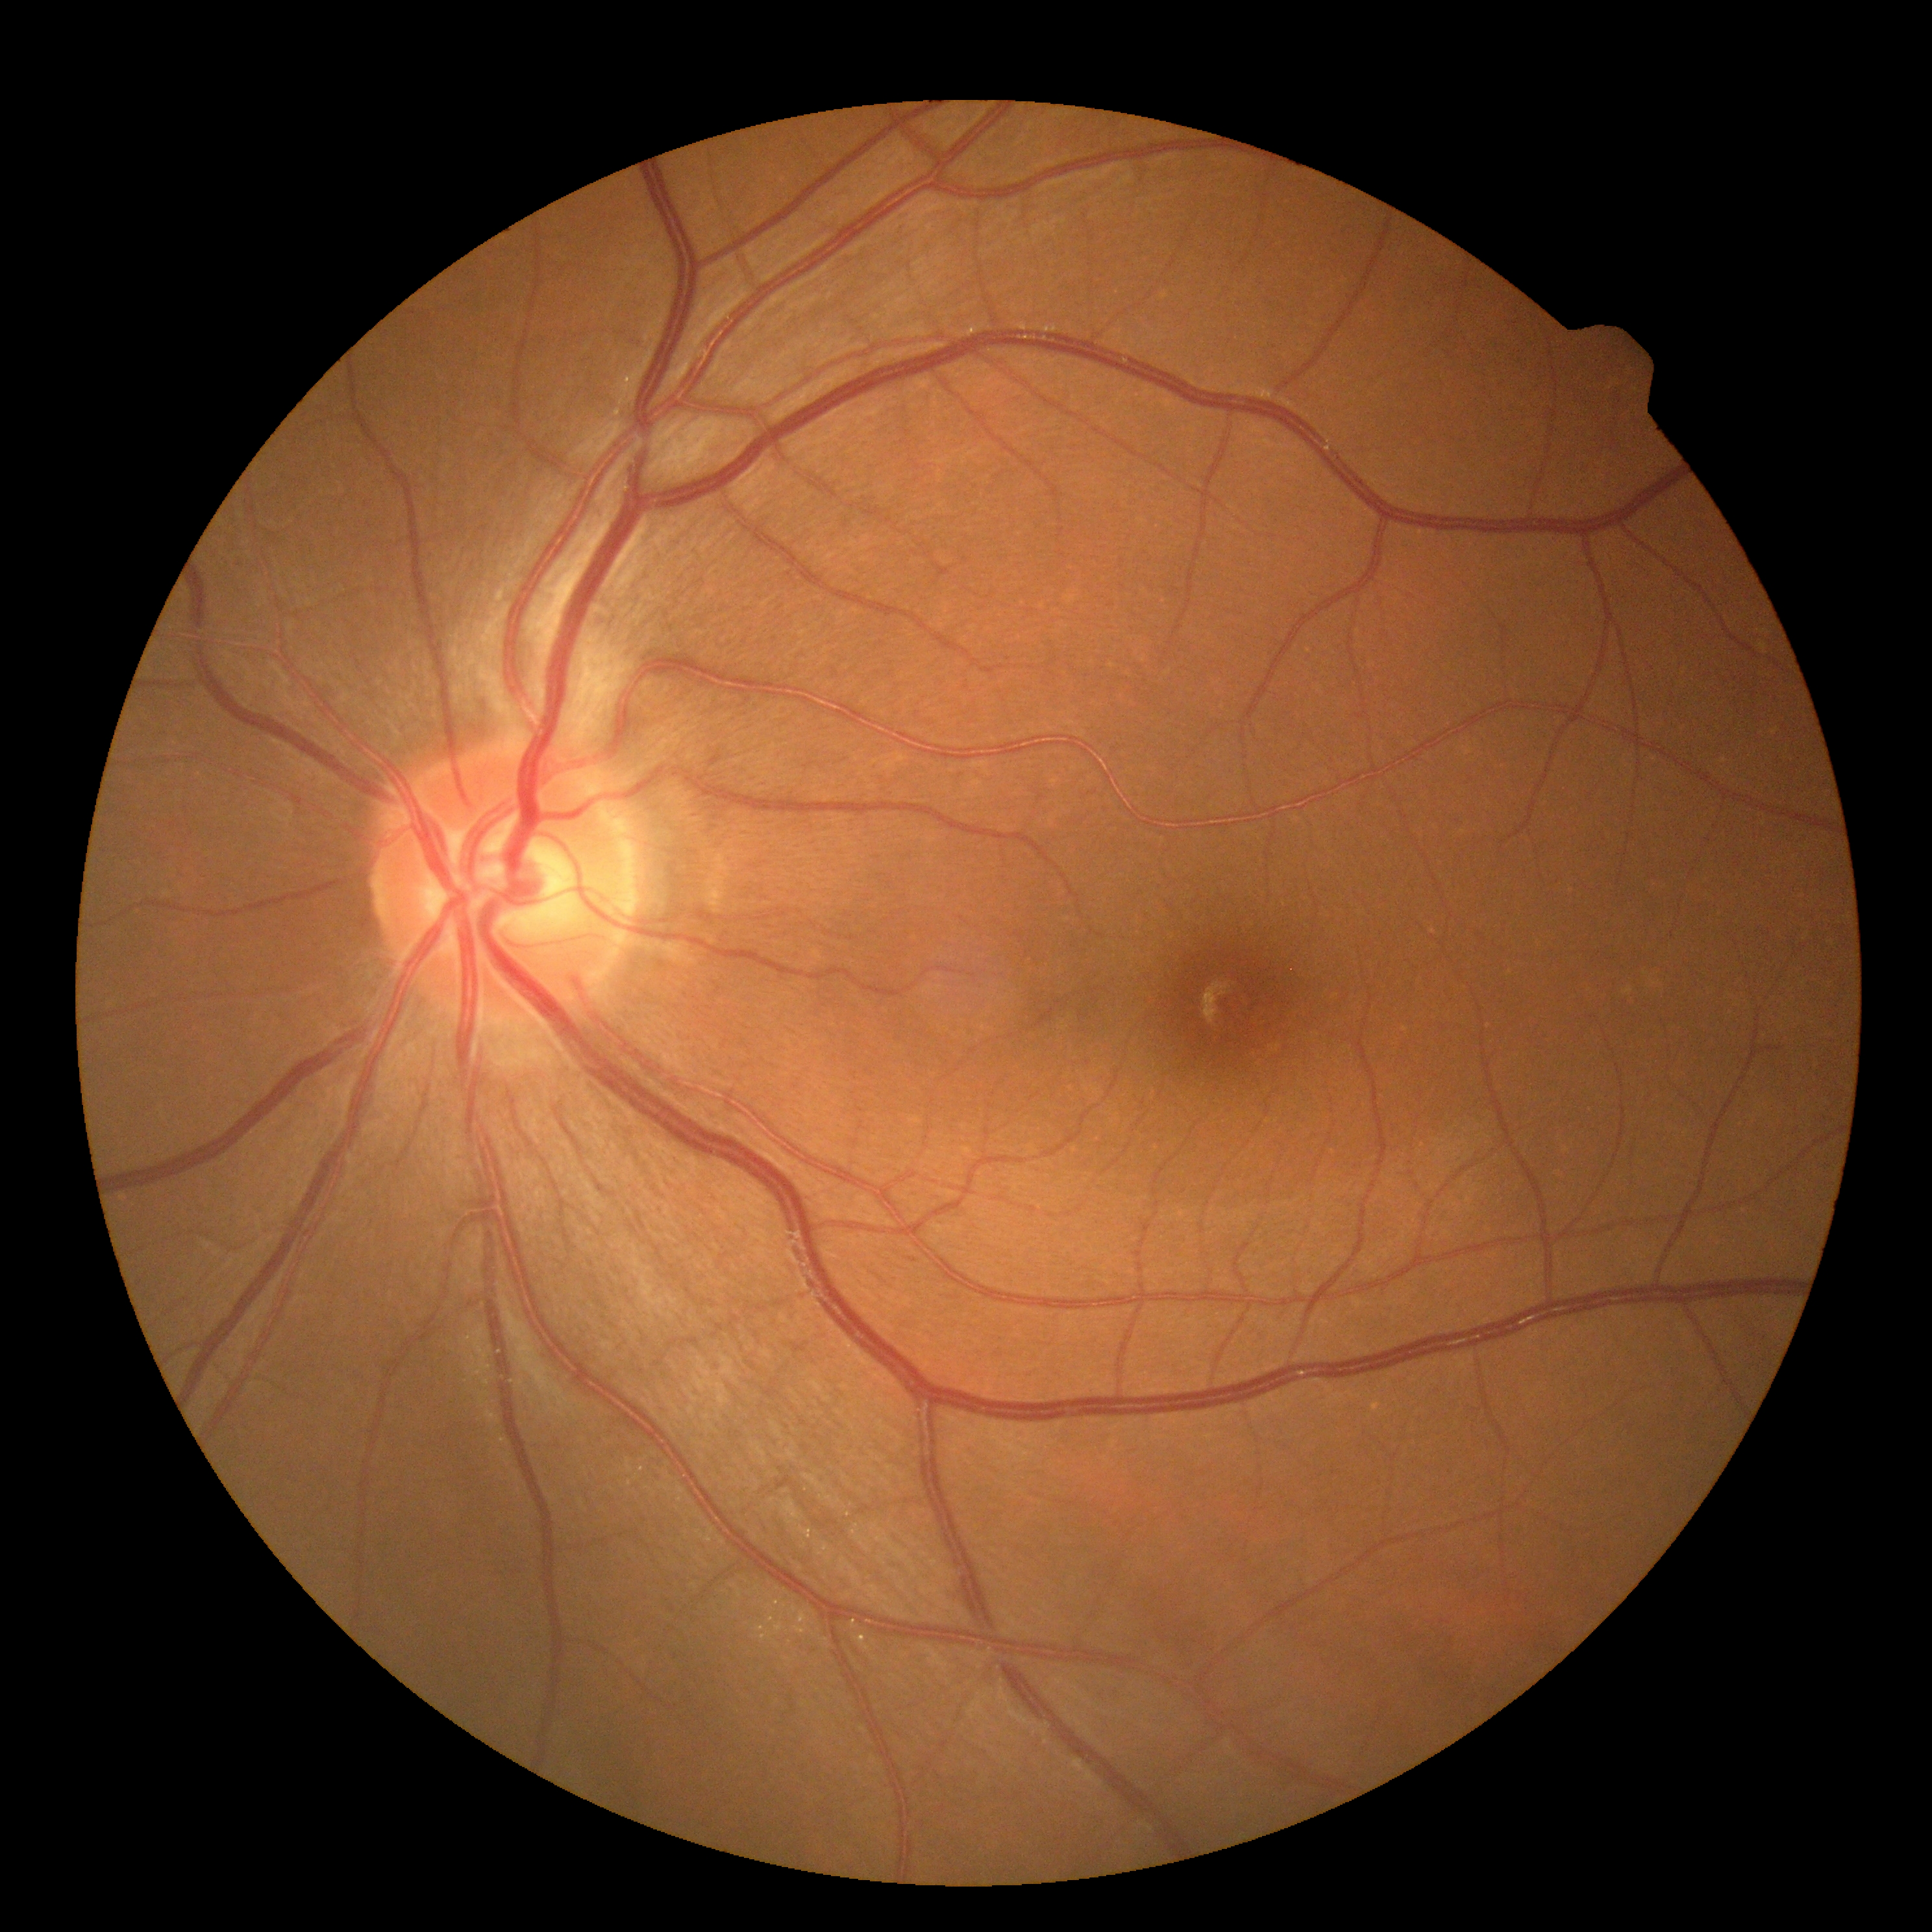

dr_impression: no apparent DR
dr_grade: no apparent diabetic retinopathy (grade 0)